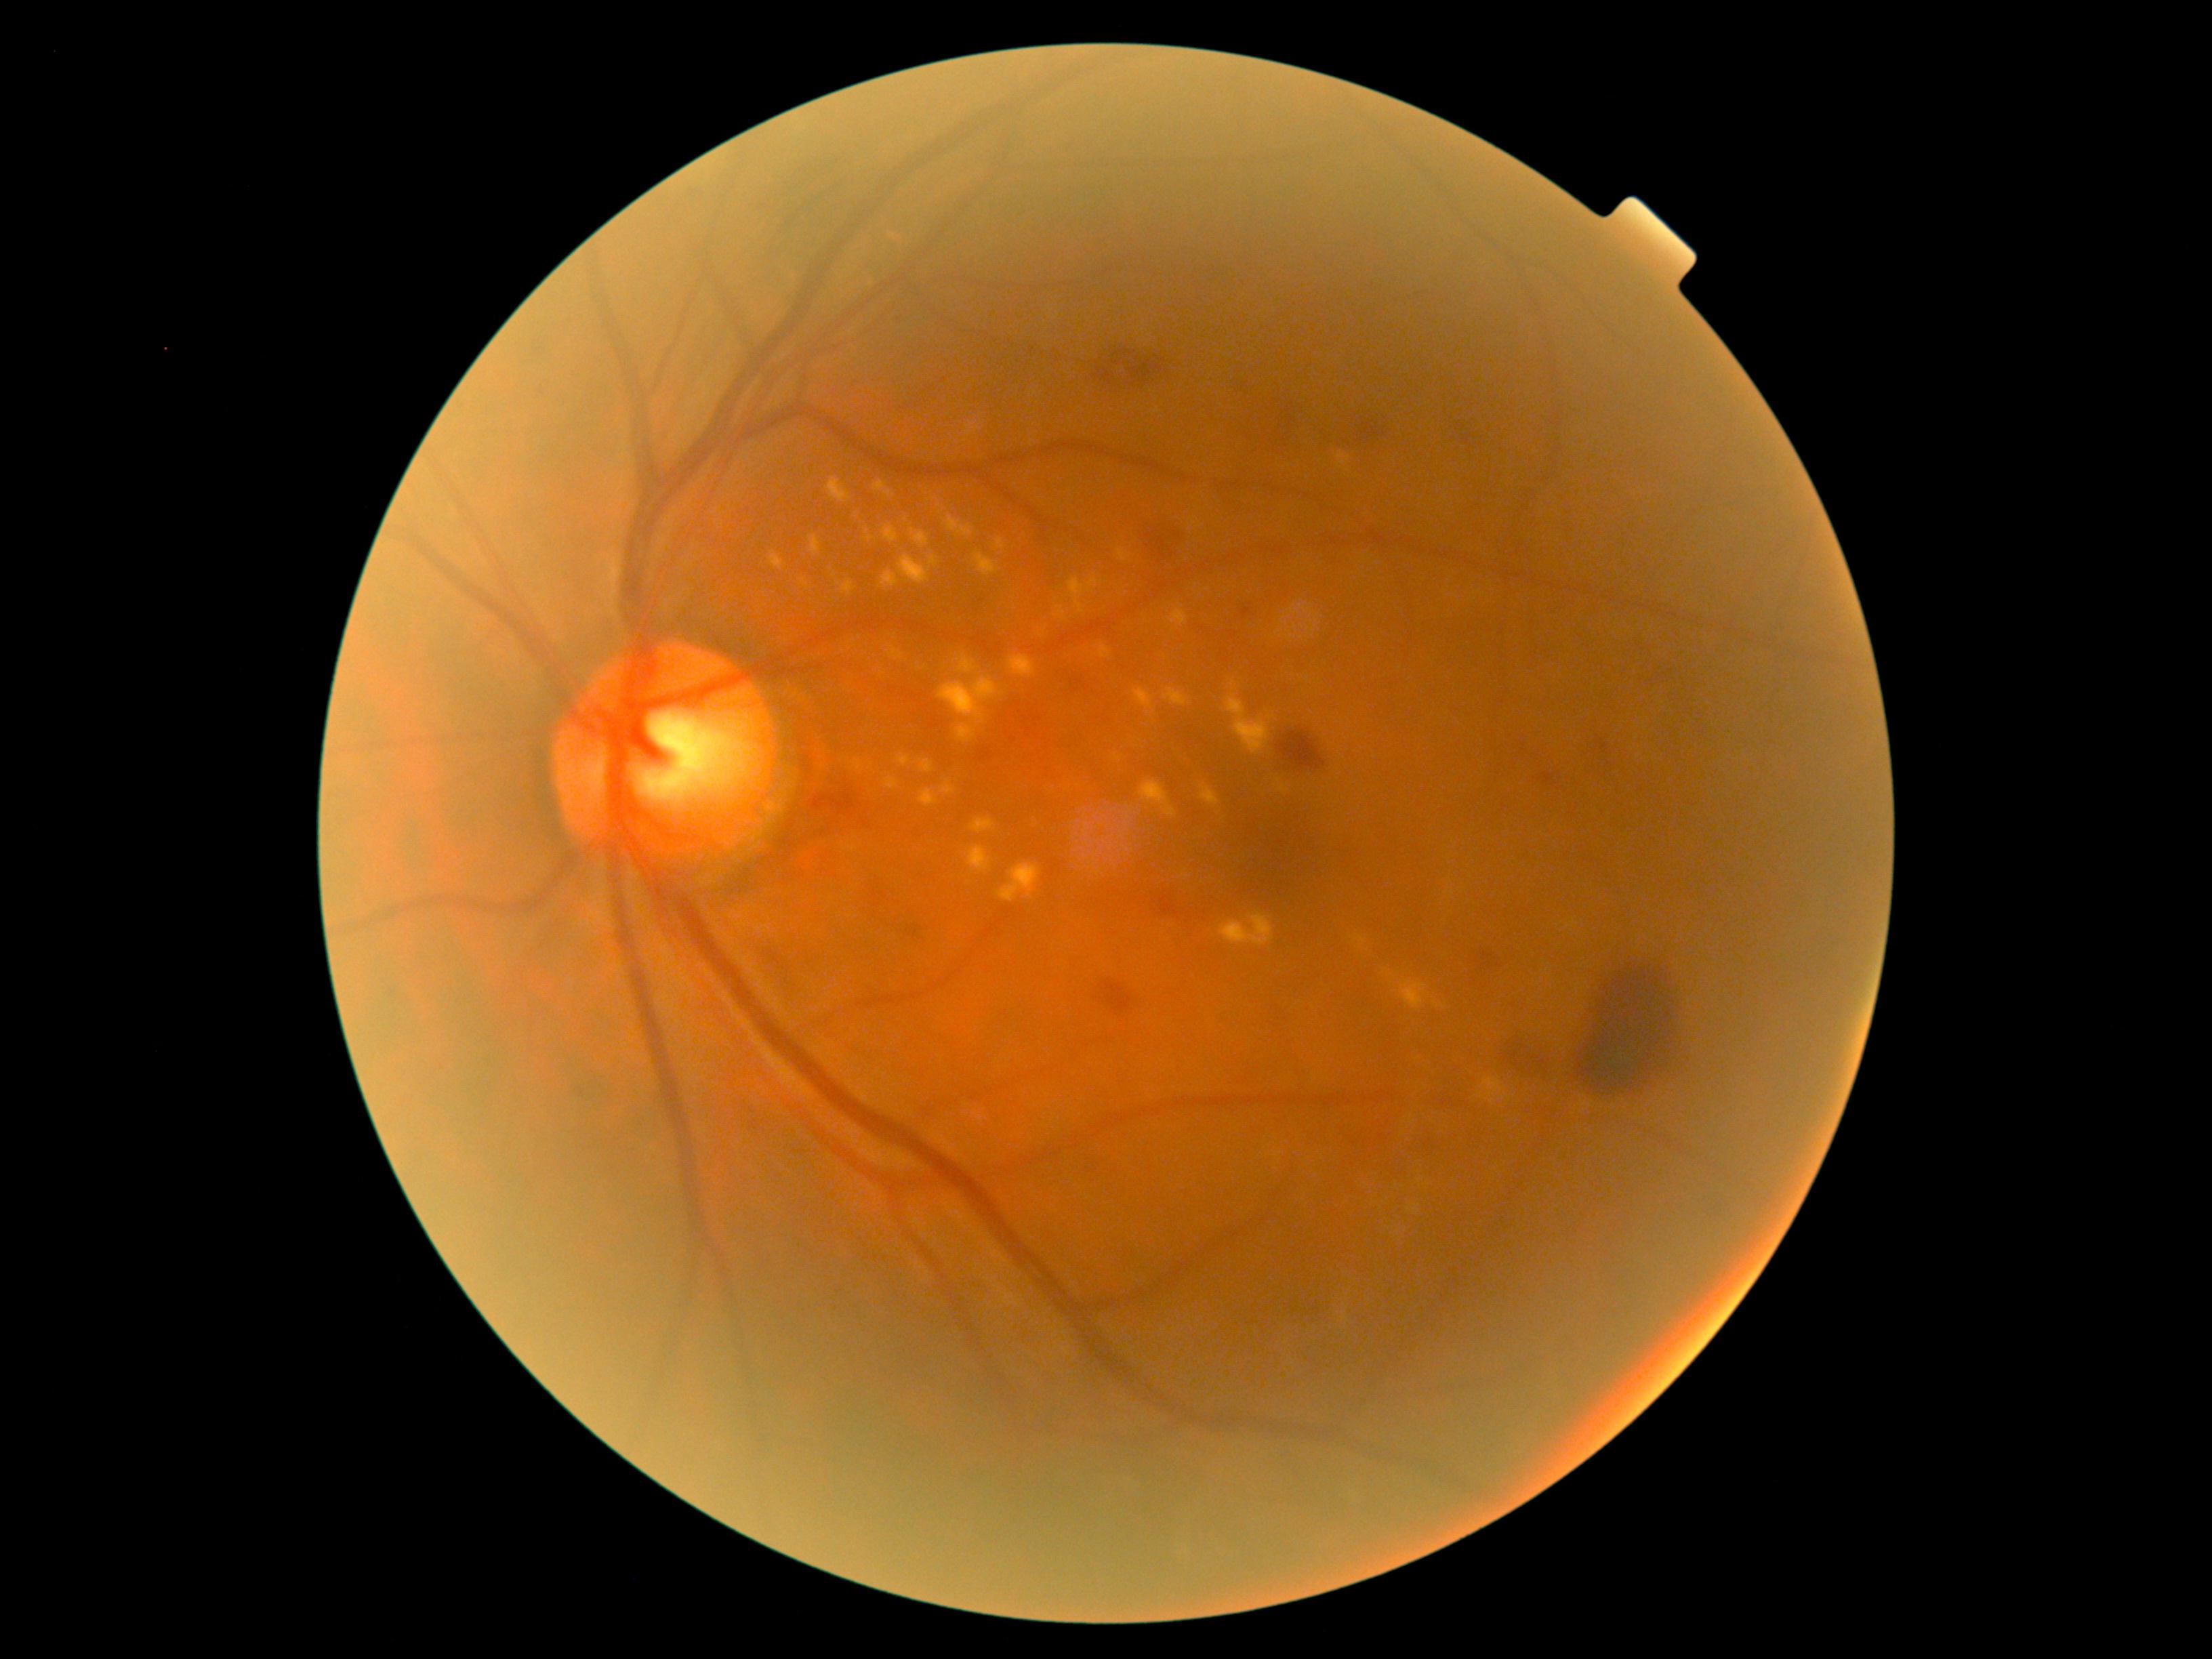
Diabetic retinopathy (DR): moderate non-proliferative diabetic retinopathy (grade 2).
Hard exudates (EXs) are present, including at 771 550 787 567 | 1162 688 1189 707 | 1009 657 1036 678 | 895 752 916 762 | 1118 550 1131 562 | 1169 605 1188 626 | 1057 607 1067 619 | 970 818 994 833 | 1221 914 1273 948 | 968 846 991 874 | 914 783 935 803 | 997 539 1005 550 | 955 704 991 738 | 1401 979 1427 1010.
EXs (small, approximate centers) near (1393,976).